Posterior pole color fundus photograph:
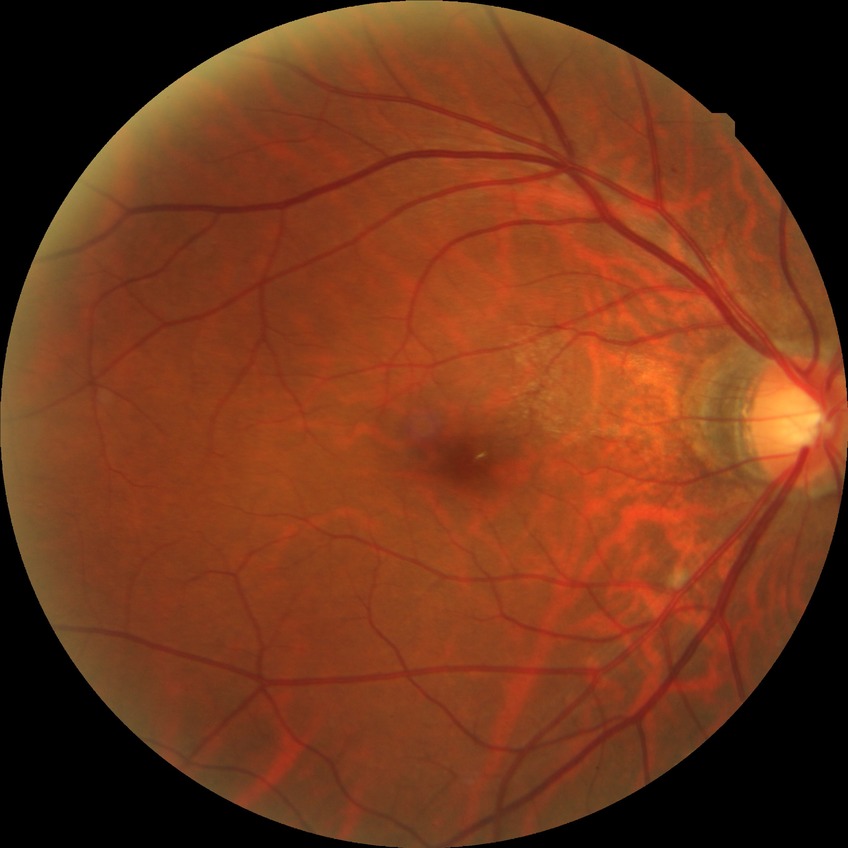 Diabetic retinopathy grade: simple diabetic retinopathy.